1440x1080; wide-field fundus photograph of an infant — 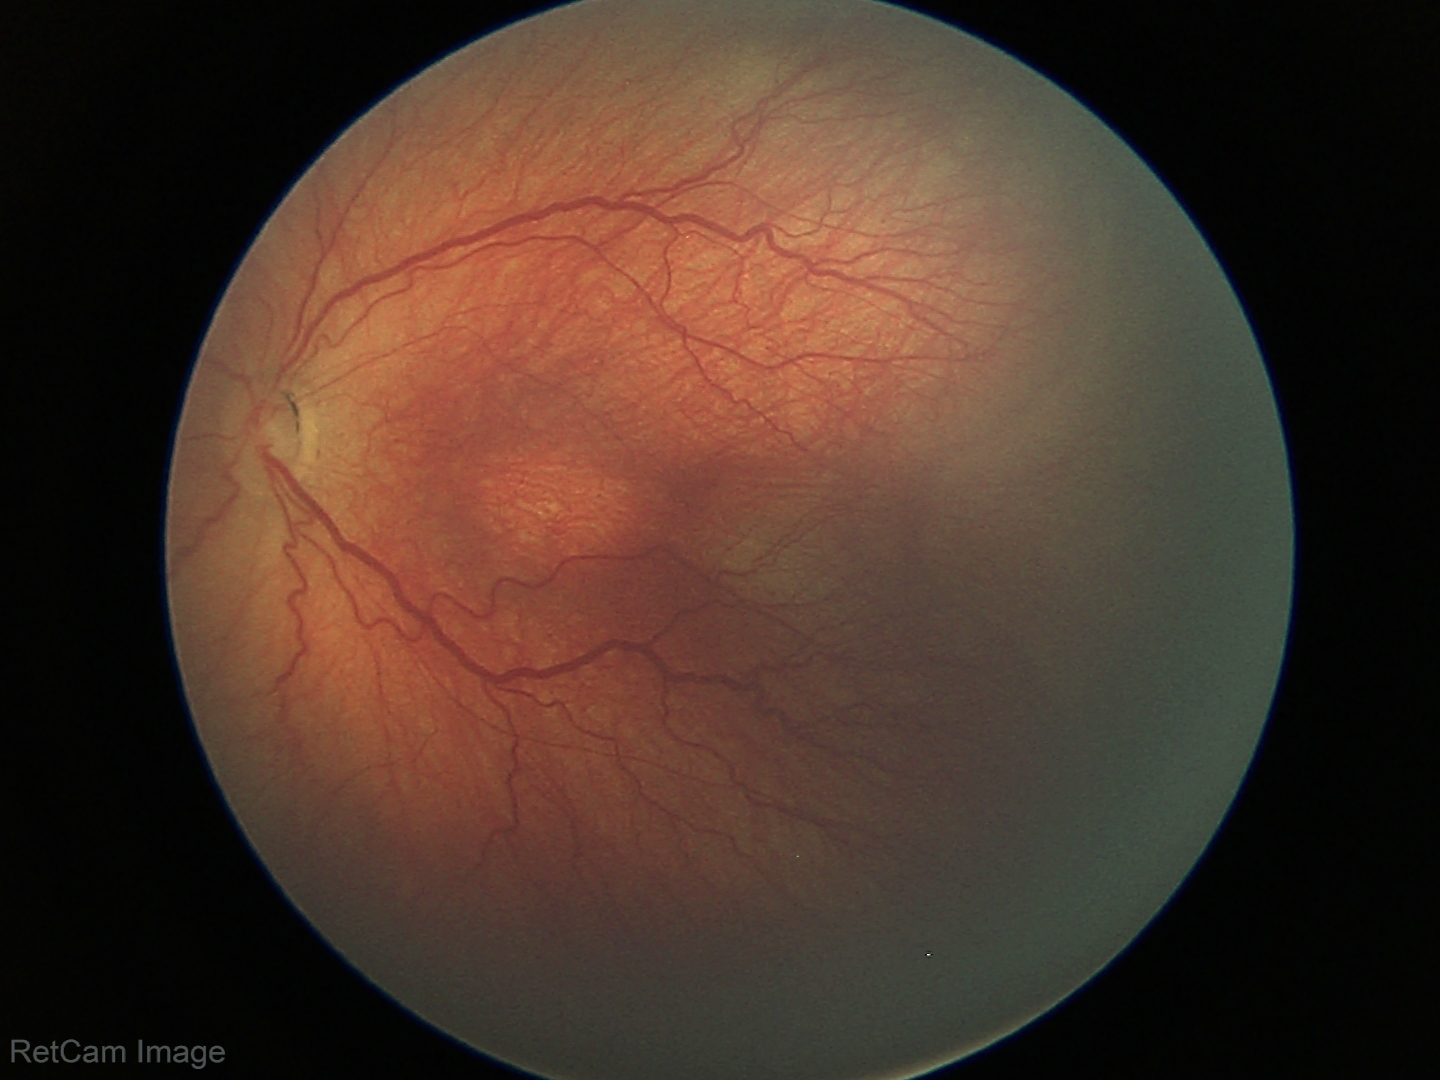 Impression: retinopathy of prematurity stage 3.